NIDEK AFC-230; FOV: 45 degrees; 848 by 848 pixels; nonmydriatic; color fundus photograph:
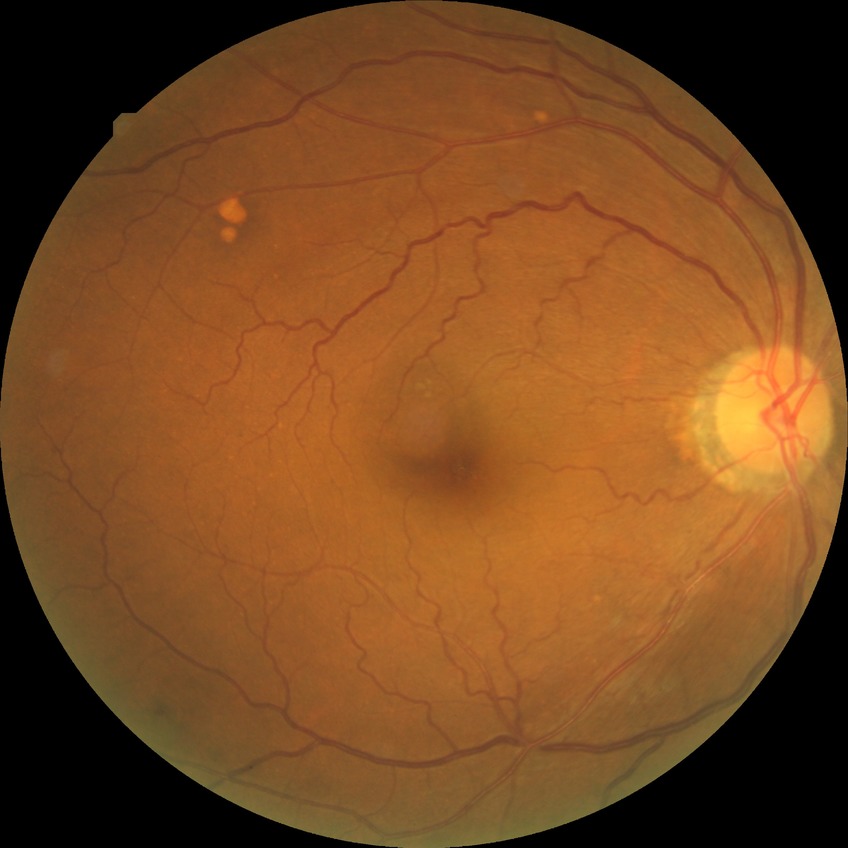
Diabetic retinopathy (DR) is simple diabetic retinopathy (SDR).